Color fundus photograph: 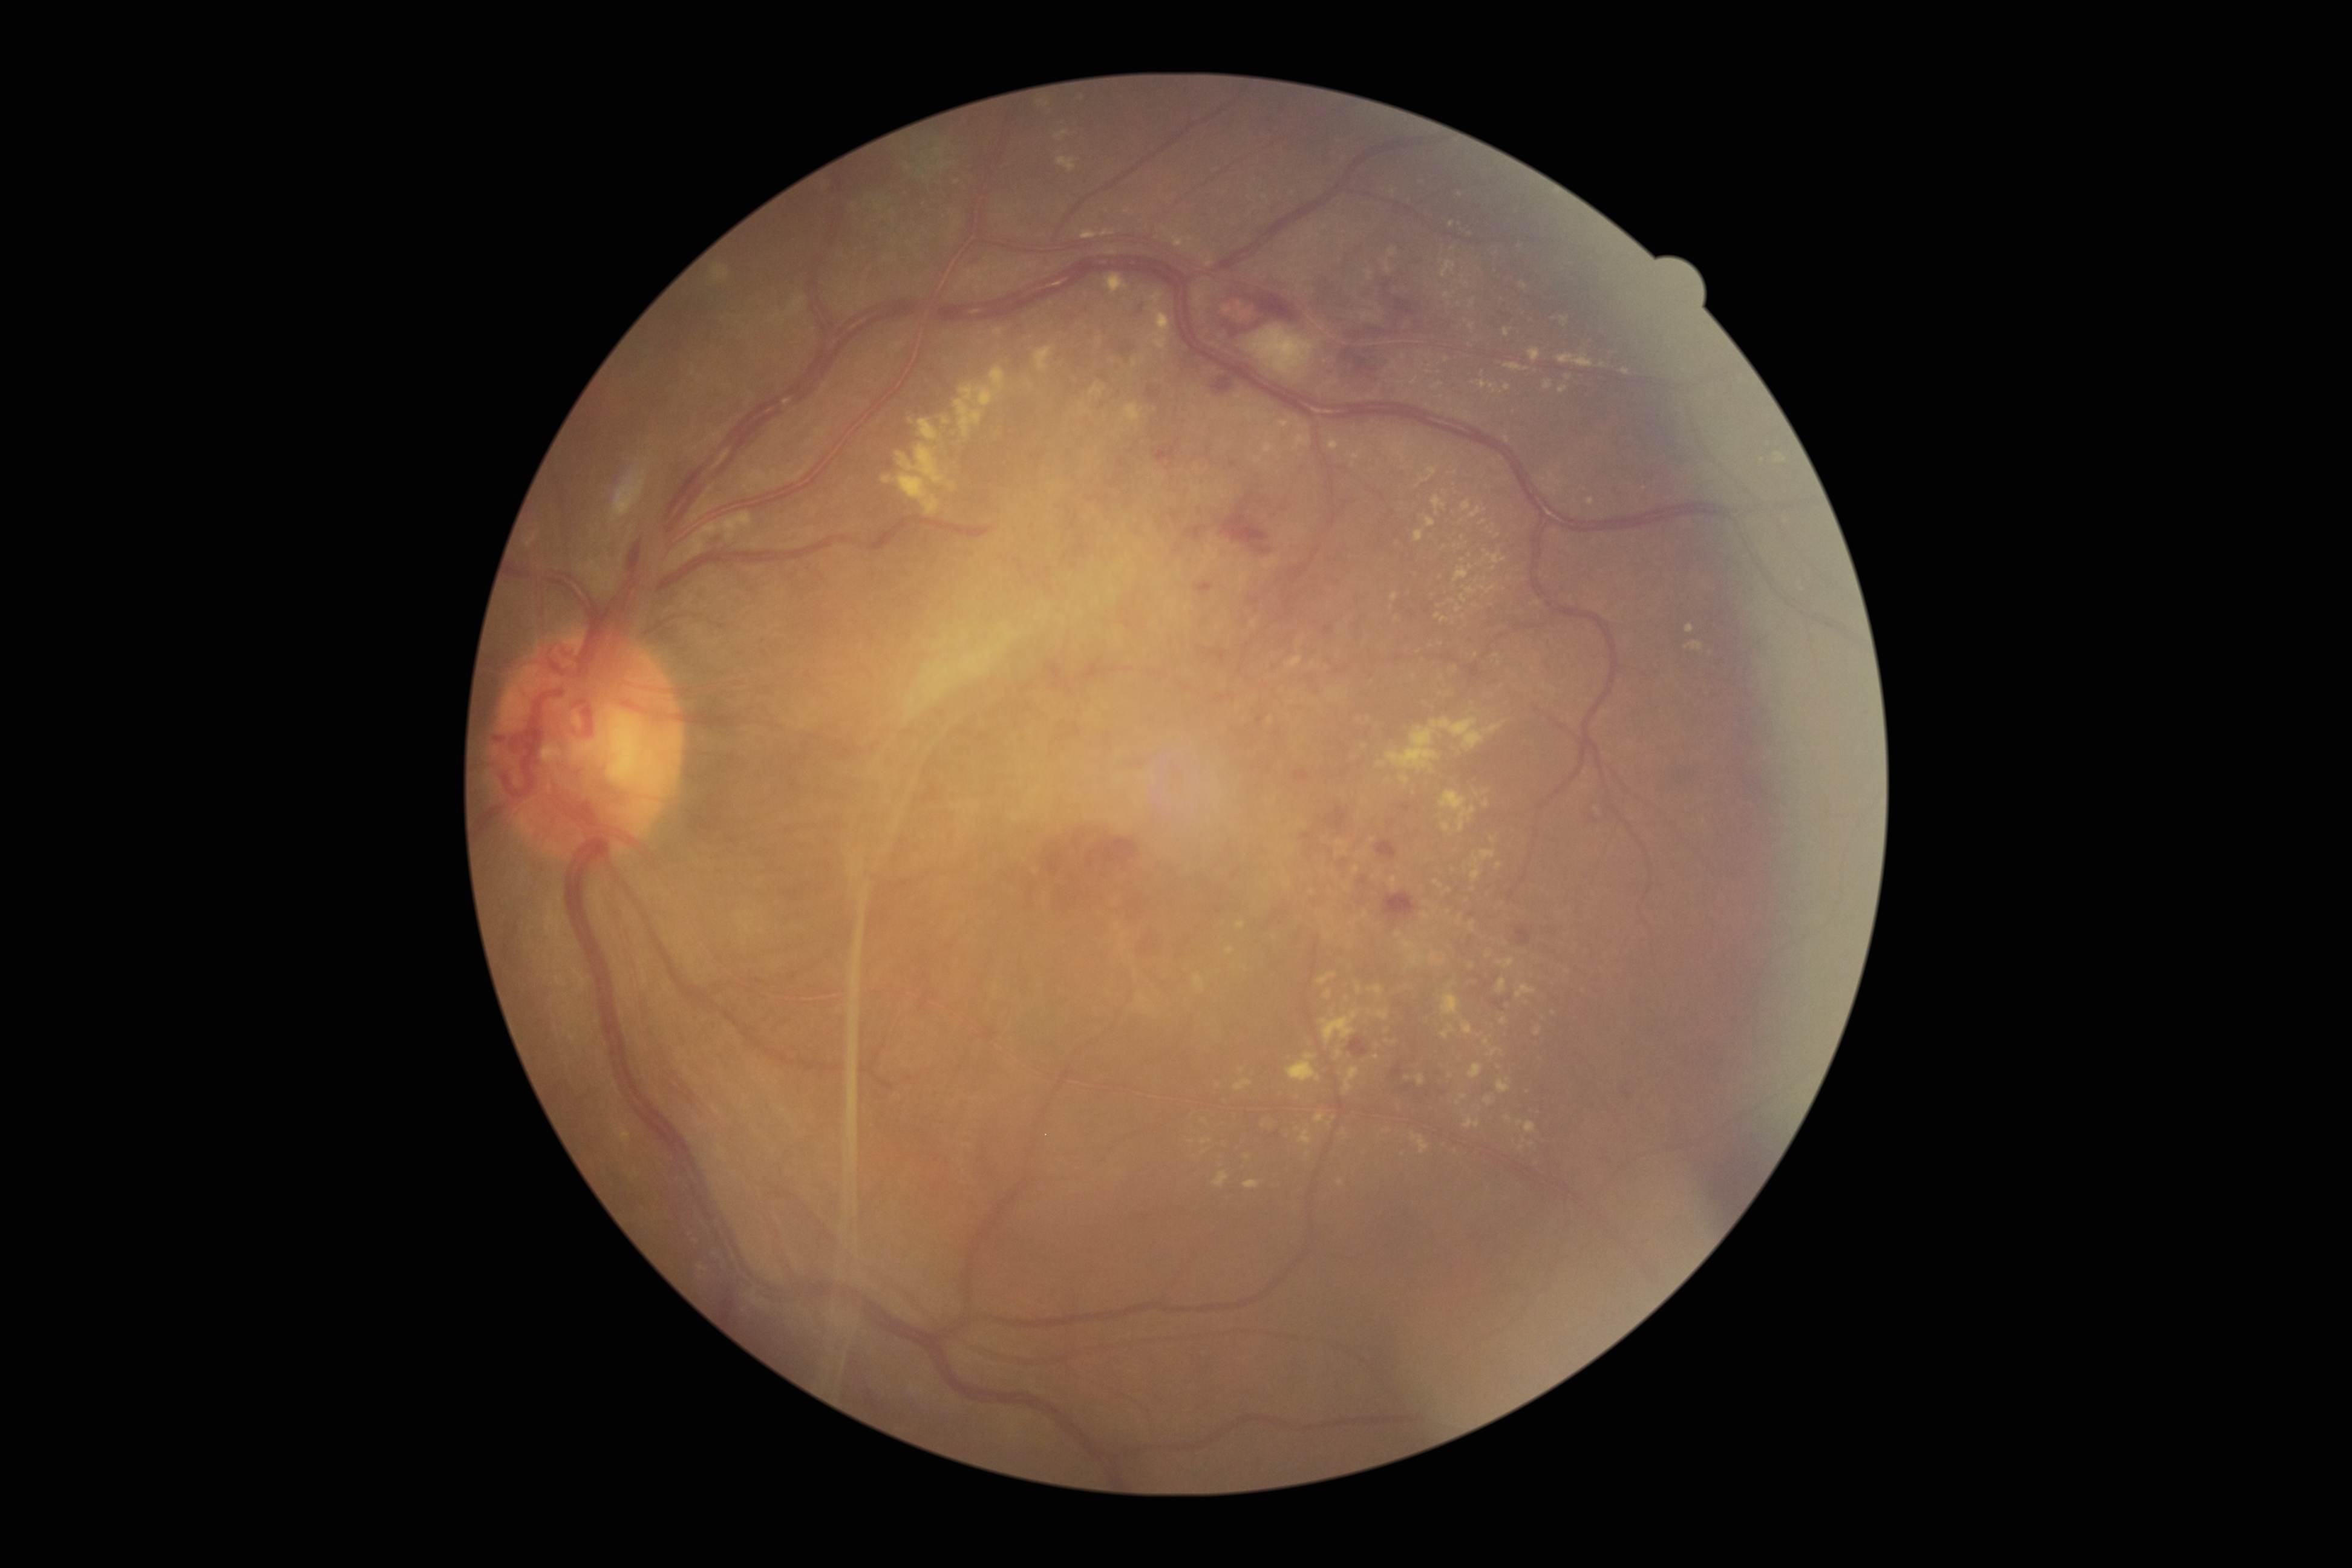
partial: true
dr_grade: 4
dr_grade_name: PDR
lesions:
  ex:
    - <bbox>1100, 229, 1116, 238</bbox>
    - <bbox>682, 511, 752, 561</bbox>
    - <bbox>1403, 938, 1419, 952</bbox>
    - <bbox>1074, 93, 1086, 99</bbox>
    - <bbox>942, 417, 952, 425</bbox>
    - <bbox>1456, 604, 1461, 613</bbox>
    - <bbox>1415, 1074, 1425, 1085</bbox>
    - <bbox>1442, 993, 1460, 1016</bbox>
    - <bbox>1496, 959, 1514, 969</bbox>
    - <bbox>1460, 595, 1467, 603</bbox>
    - <bbox>1318, 972, 1338, 985</bbox>
  ex_small_centers:
    - Point(1036, 872)
    - Point(1476, 655)
    - Point(1458, 1103)
    - Point(1568, 378)
    - Point(1458, 305)
    - Point(1377, 393)
    - Point(1329, 935)
    - Point(1471, 327)
    - Point(1380, 874)